Color fundus photograph: 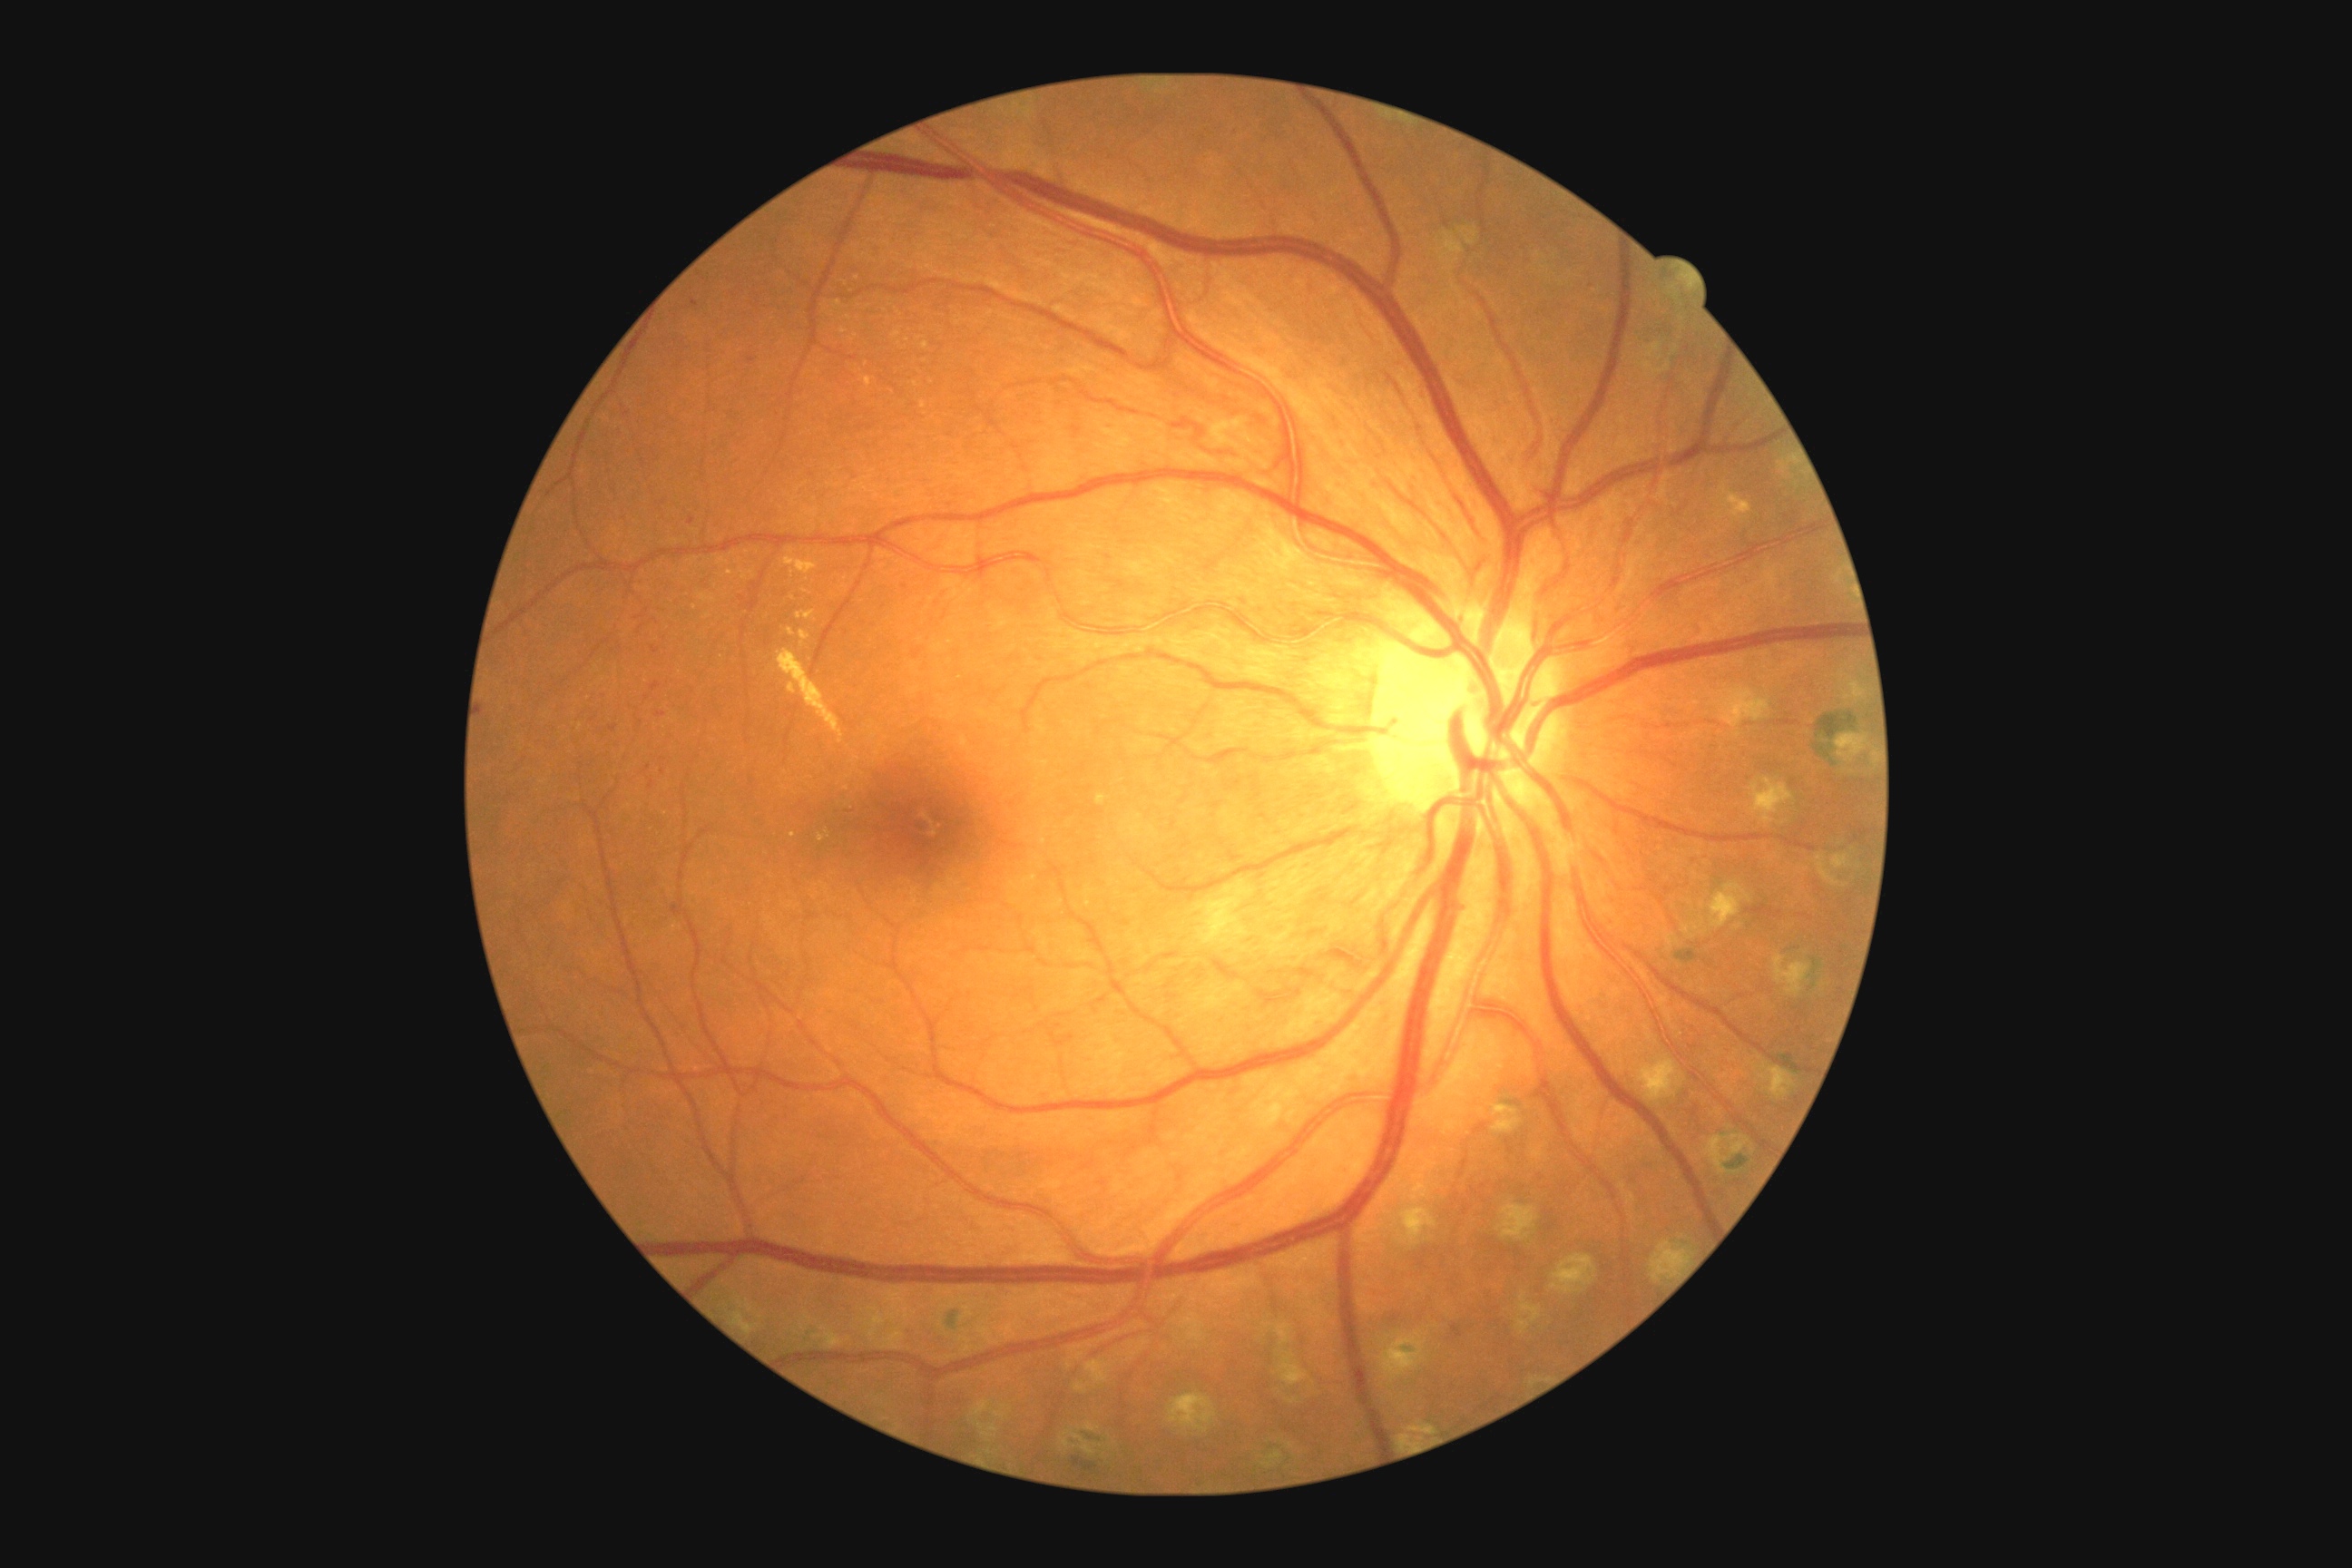 partial: true
dr_grade: 2
dr_grade_name: moderate NPDR
lesions:
  ma: []
  se: []
  ex:
    - [x1=778, y1=651, x2=845, y2=745]
    - [x1=785, y1=556, x2=818, y2=574]
    - [x1=834, y1=300, x2=843, y2=309]
    - [x1=818, y1=834, x2=825, y2=843]
    - [x1=799, y1=631, x2=810, y2=647]
    - [x1=863, y1=377, x2=872, y2=387]
  ex_small_centers:
    - (852; 340)
    - (844; 332)
    - (828; 835)
    - (915; 384)
    - (923; 405)
    - (694; 608)
    - (730; 573)
  he:
    - [x1=843, y1=801, x2=858, y2=814]
    - [x1=656, y1=712, x2=667, y2=718]
    - [x1=651, y1=681, x2=662, y2=692]
    - [x1=651, y1=647, x2=660, y2=654]
    - [x1=600, y1=692, x2=607, y2=700]
    - [x1=649, y1=781, x2=654, y2=789]
    - [x1=609, y1=725, x2=618, y2=732]
    - [x1=691, y1=299, x2=700, y2=308]
  he_small_centers:
    - (663; 773)
    - (692; 521)
    - (648; 698)
    - (663; 503)
    - (752; 361)
    - (648; 769)
    - (593; 719)